45° field of view.
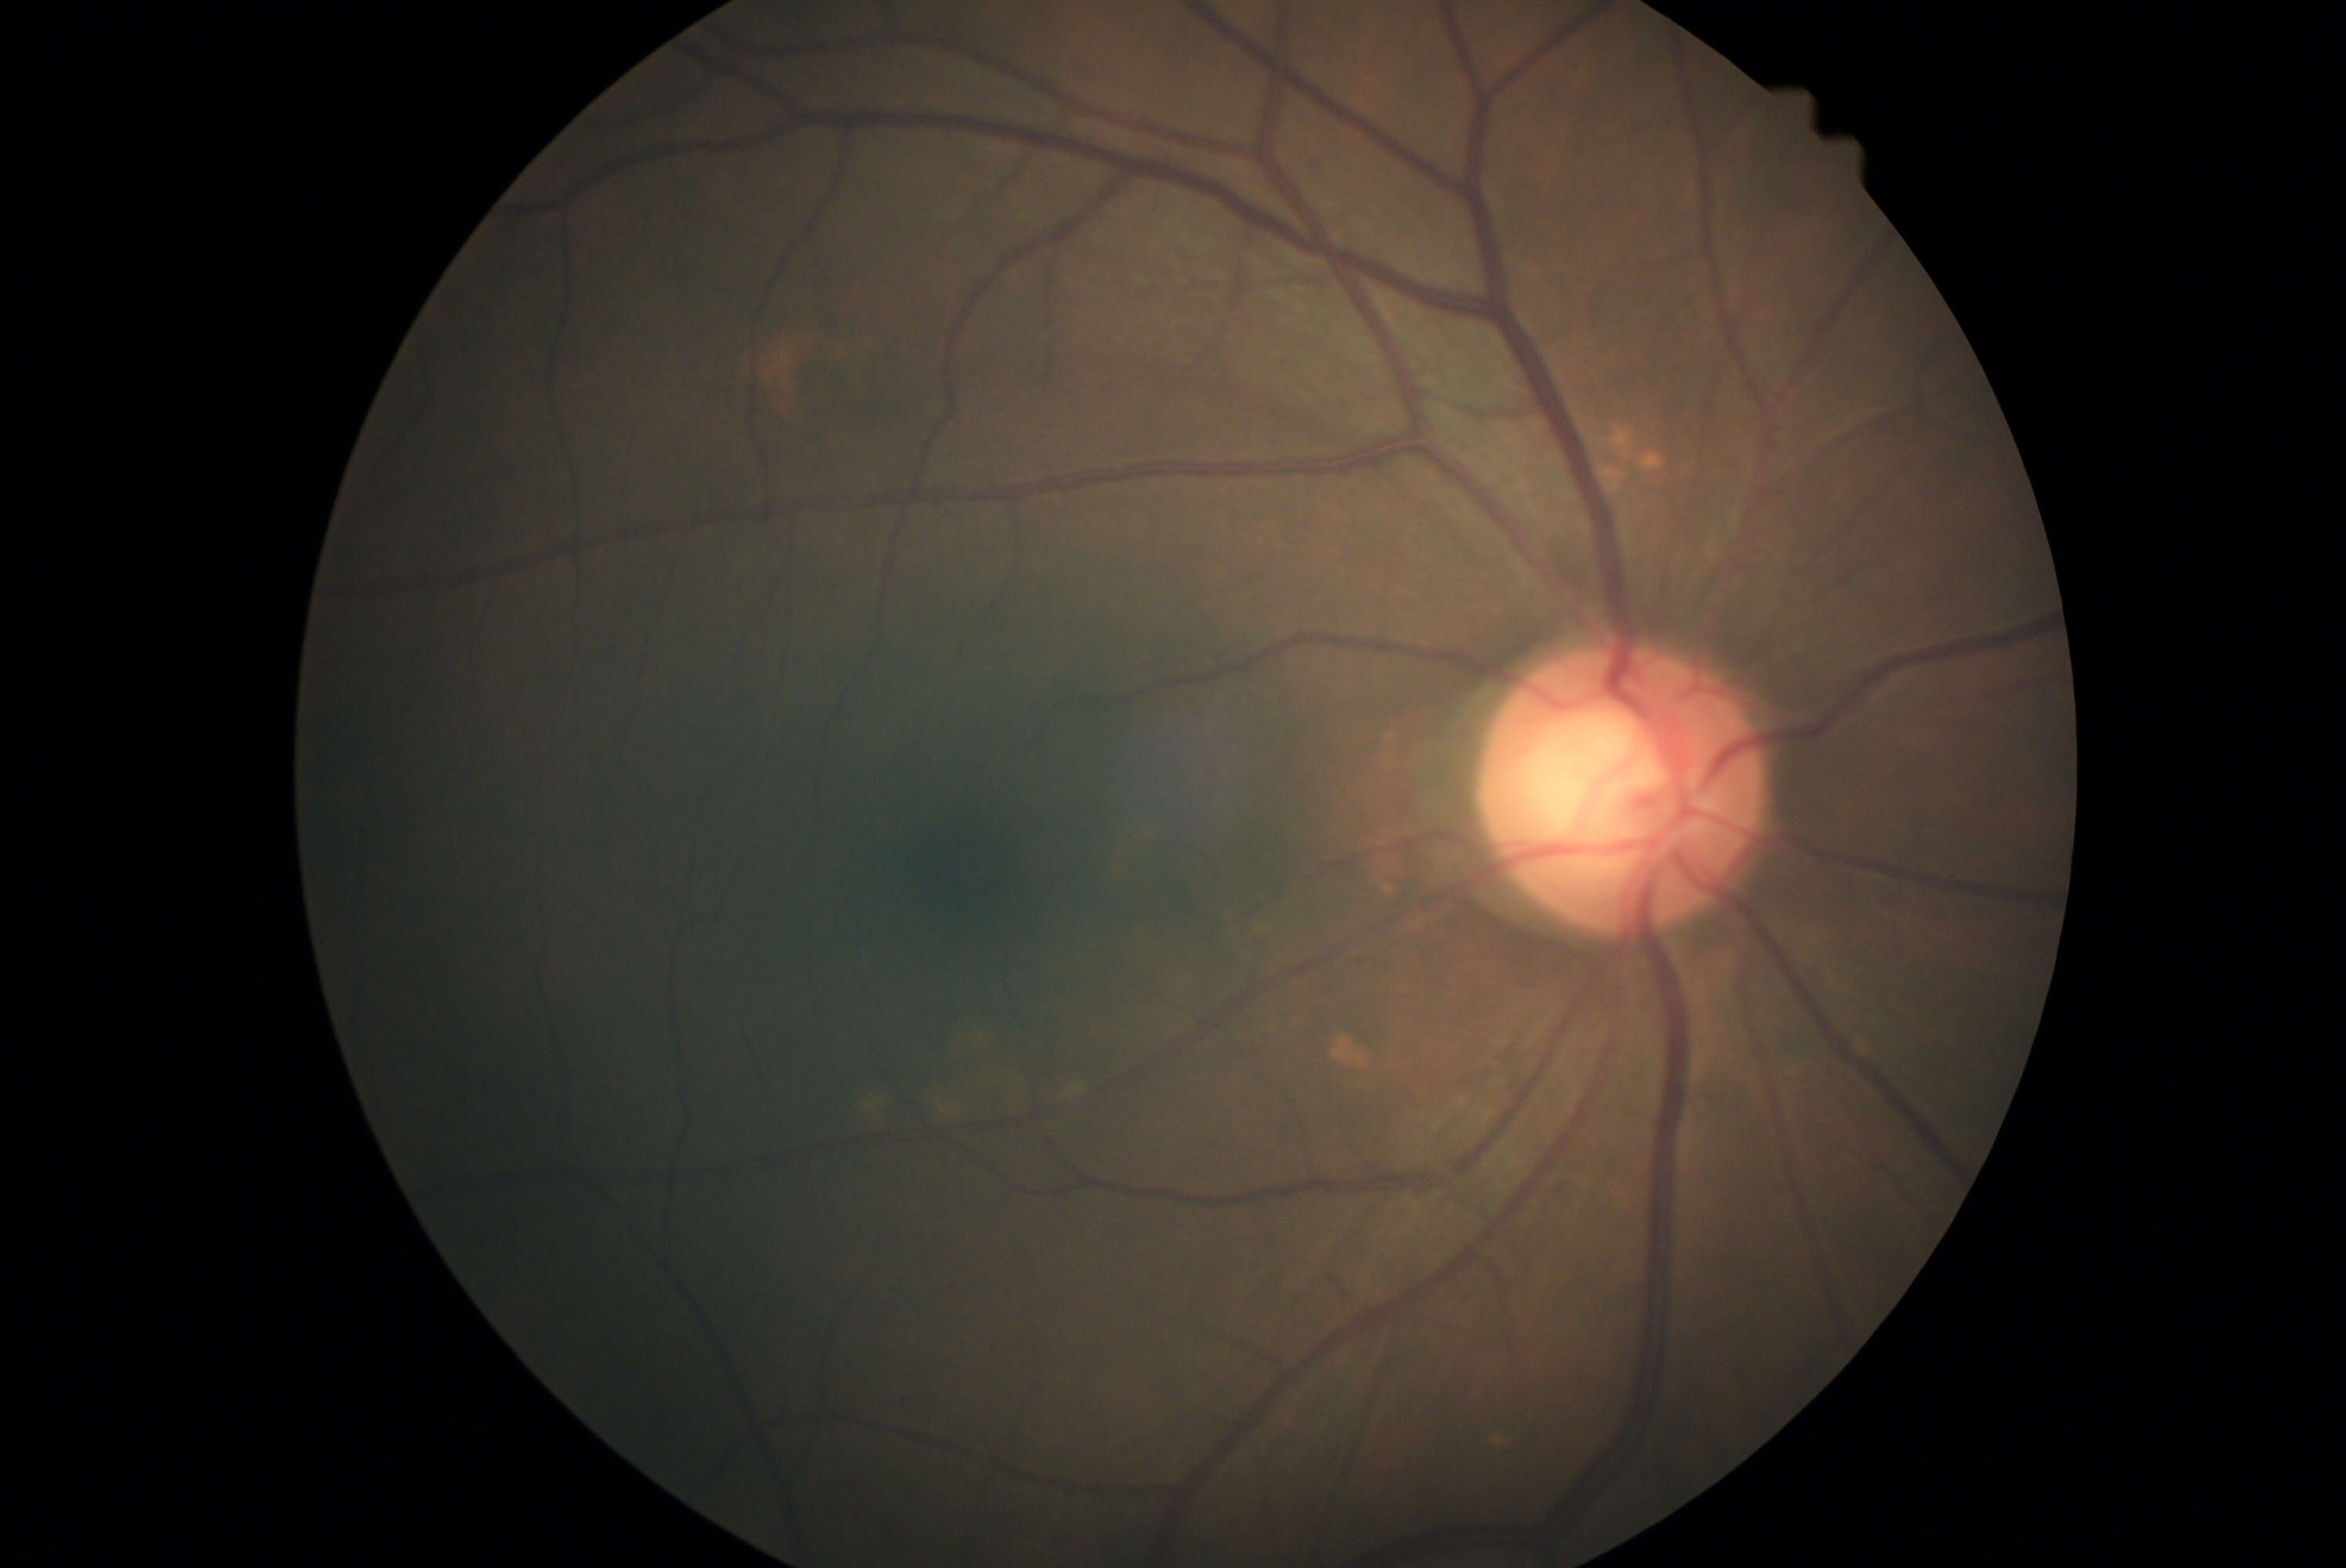

Retinopathy grade: no apparent retinopathy (0). No signs of diabetic retinopathy.